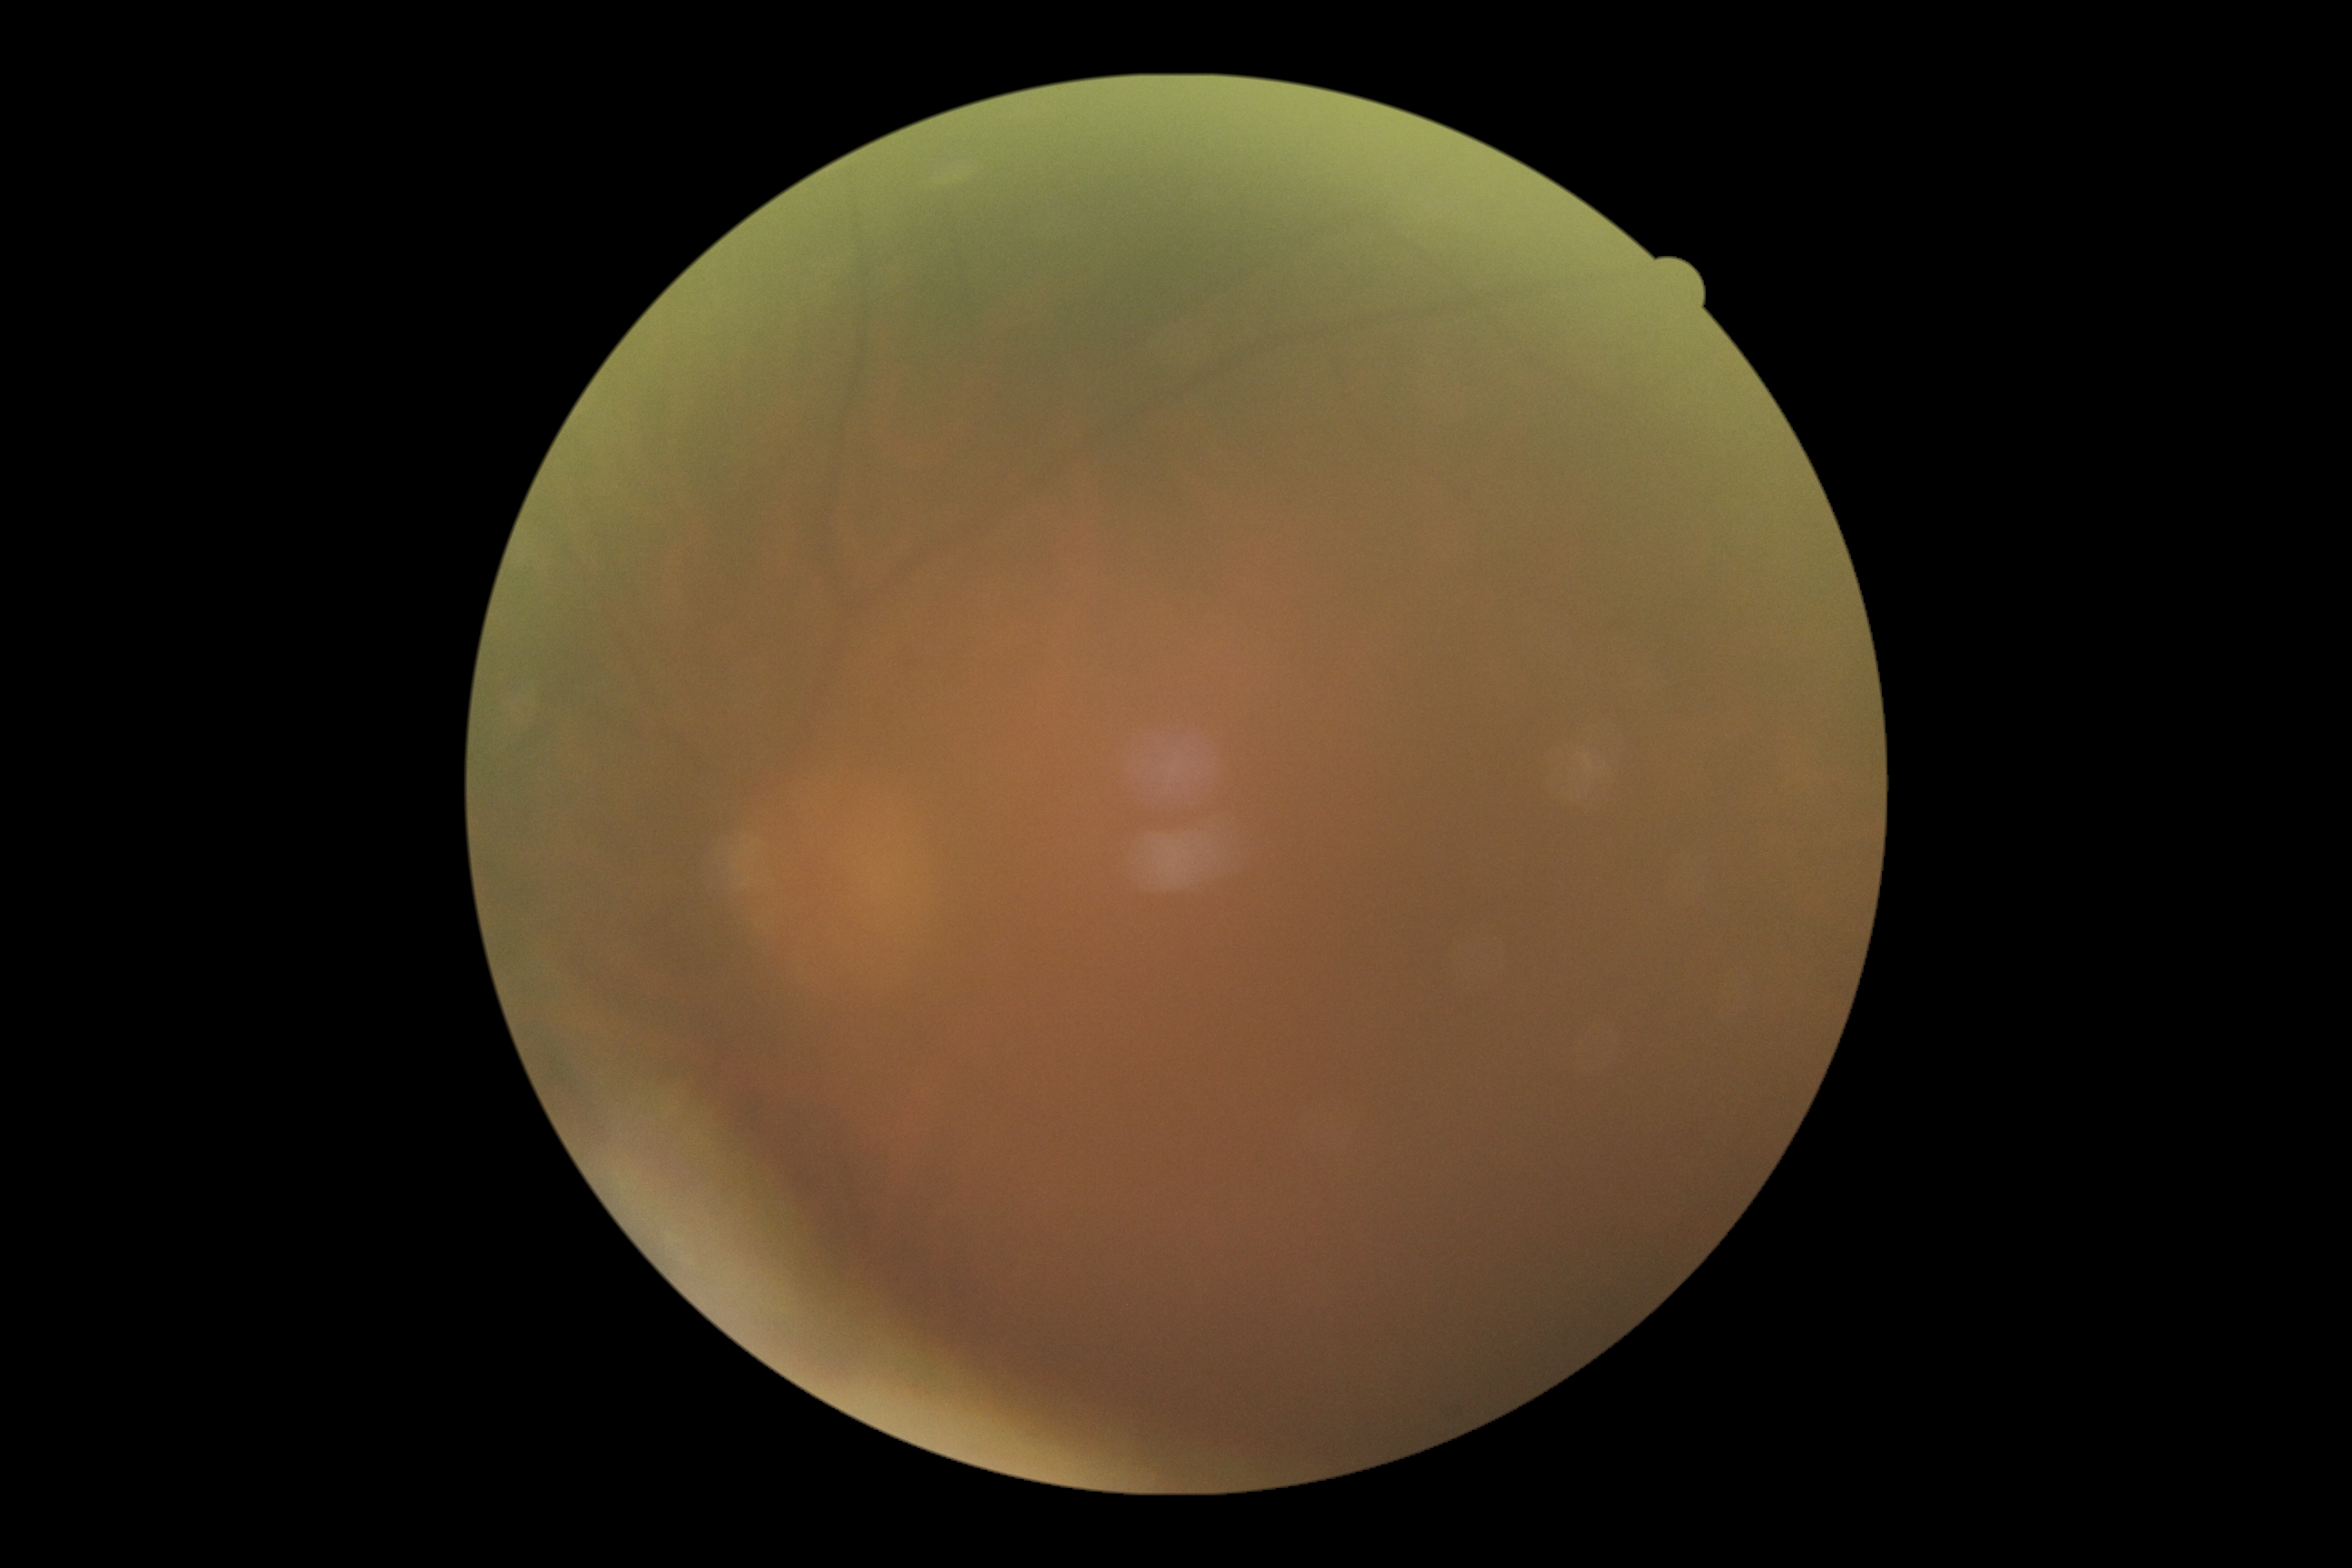

image quality=insufficient for DR assessment, diabetic retinopathy (DR)=ungradable due to poor image quality.